Image size 640x480; 130° field of view (Clarity RetCam 3); wide-field fundus photograph of an infant:
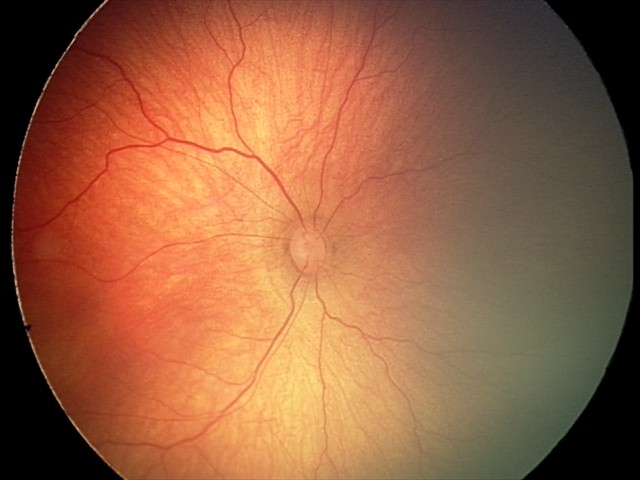
Impression: retinopathy of prematurity (ROP) stage 2